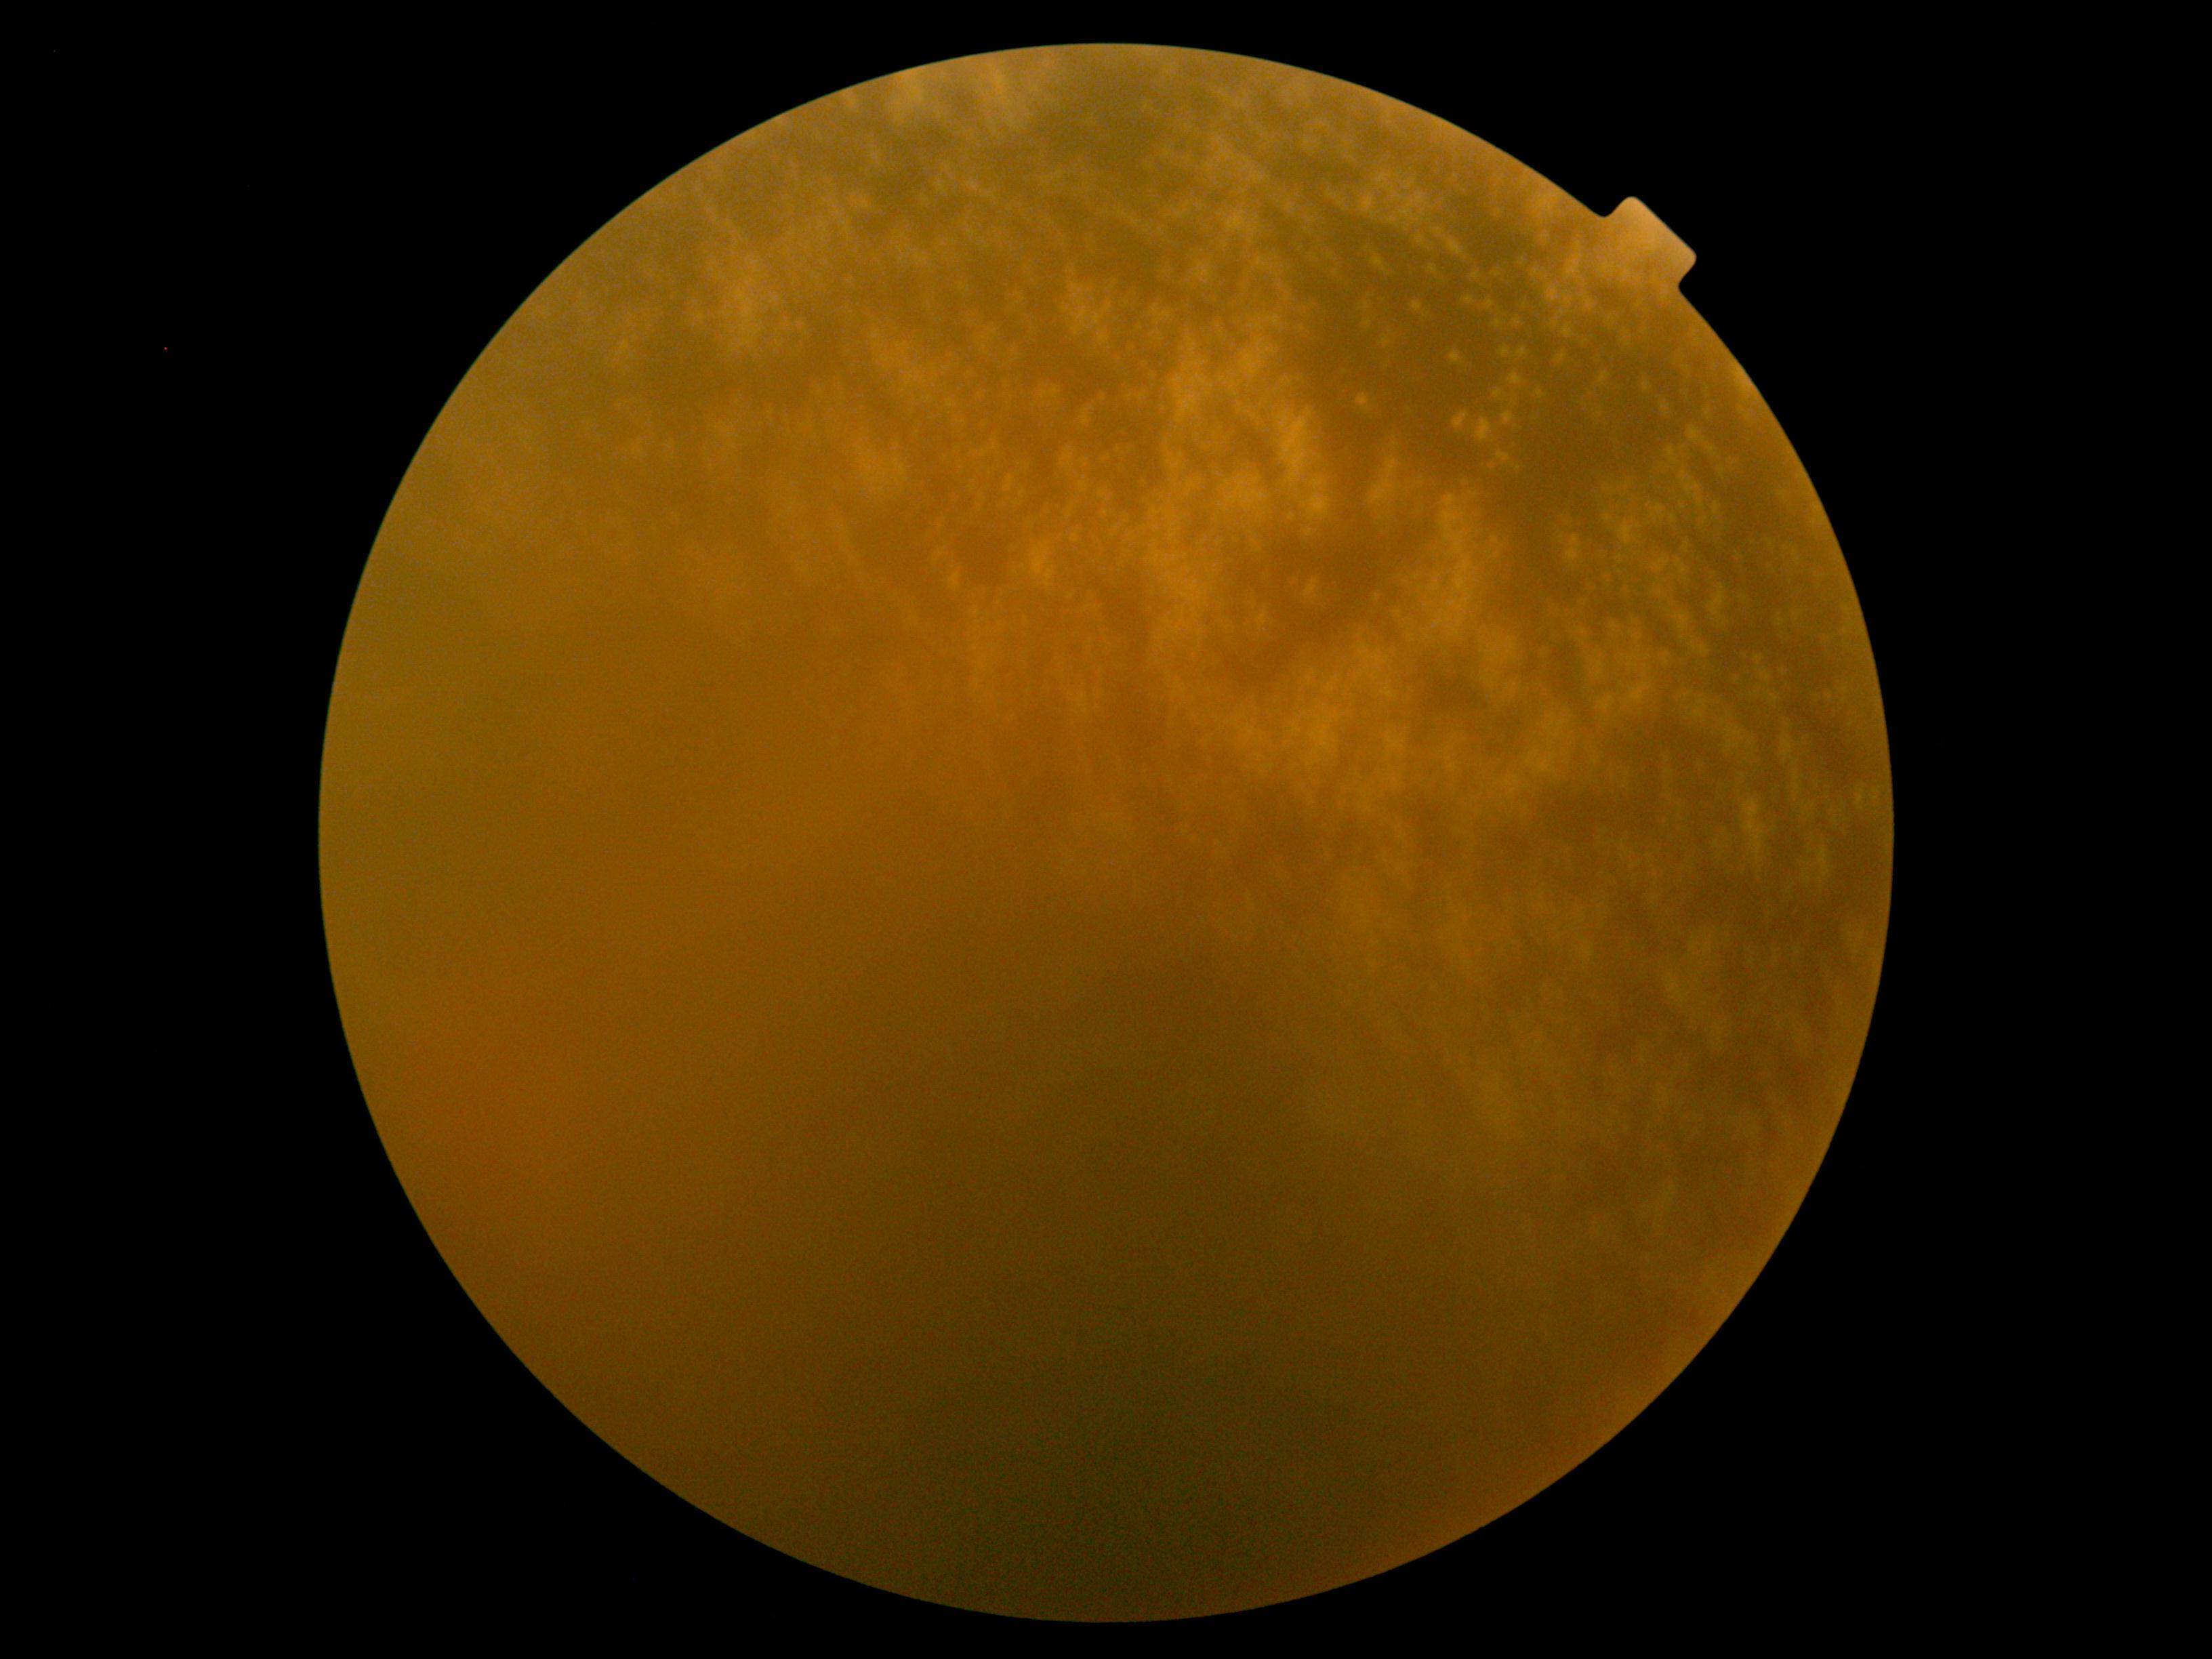

Retinopathy grade: ungradable.